Color fundus photograph; image size 848x848; modified Davis grading
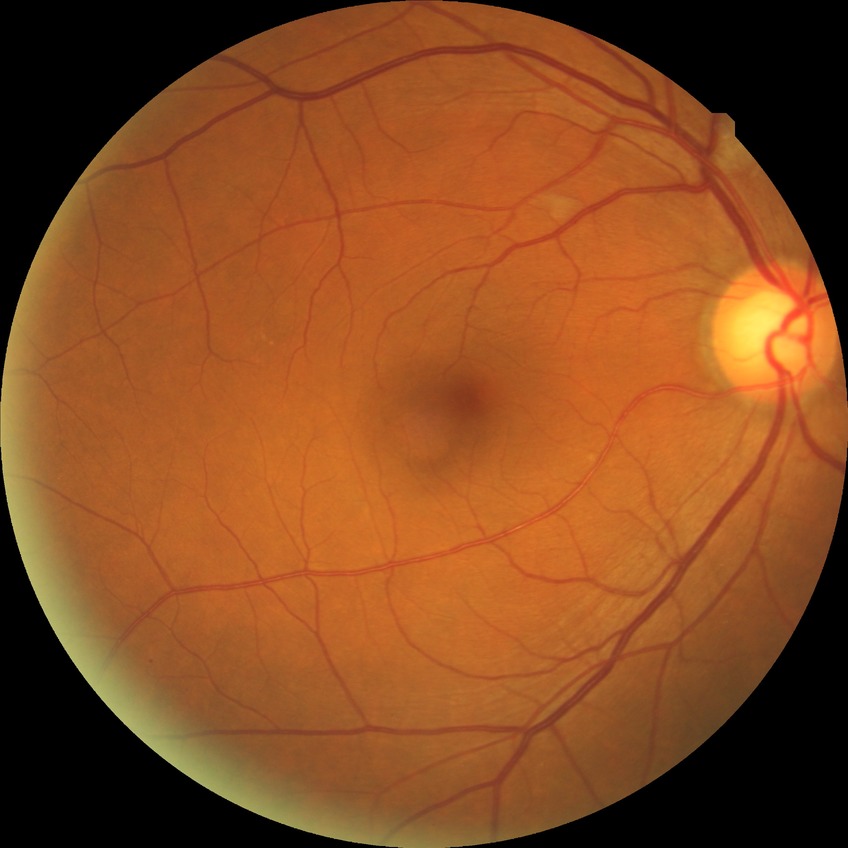

Davis grading: no diabetic retinopathy.